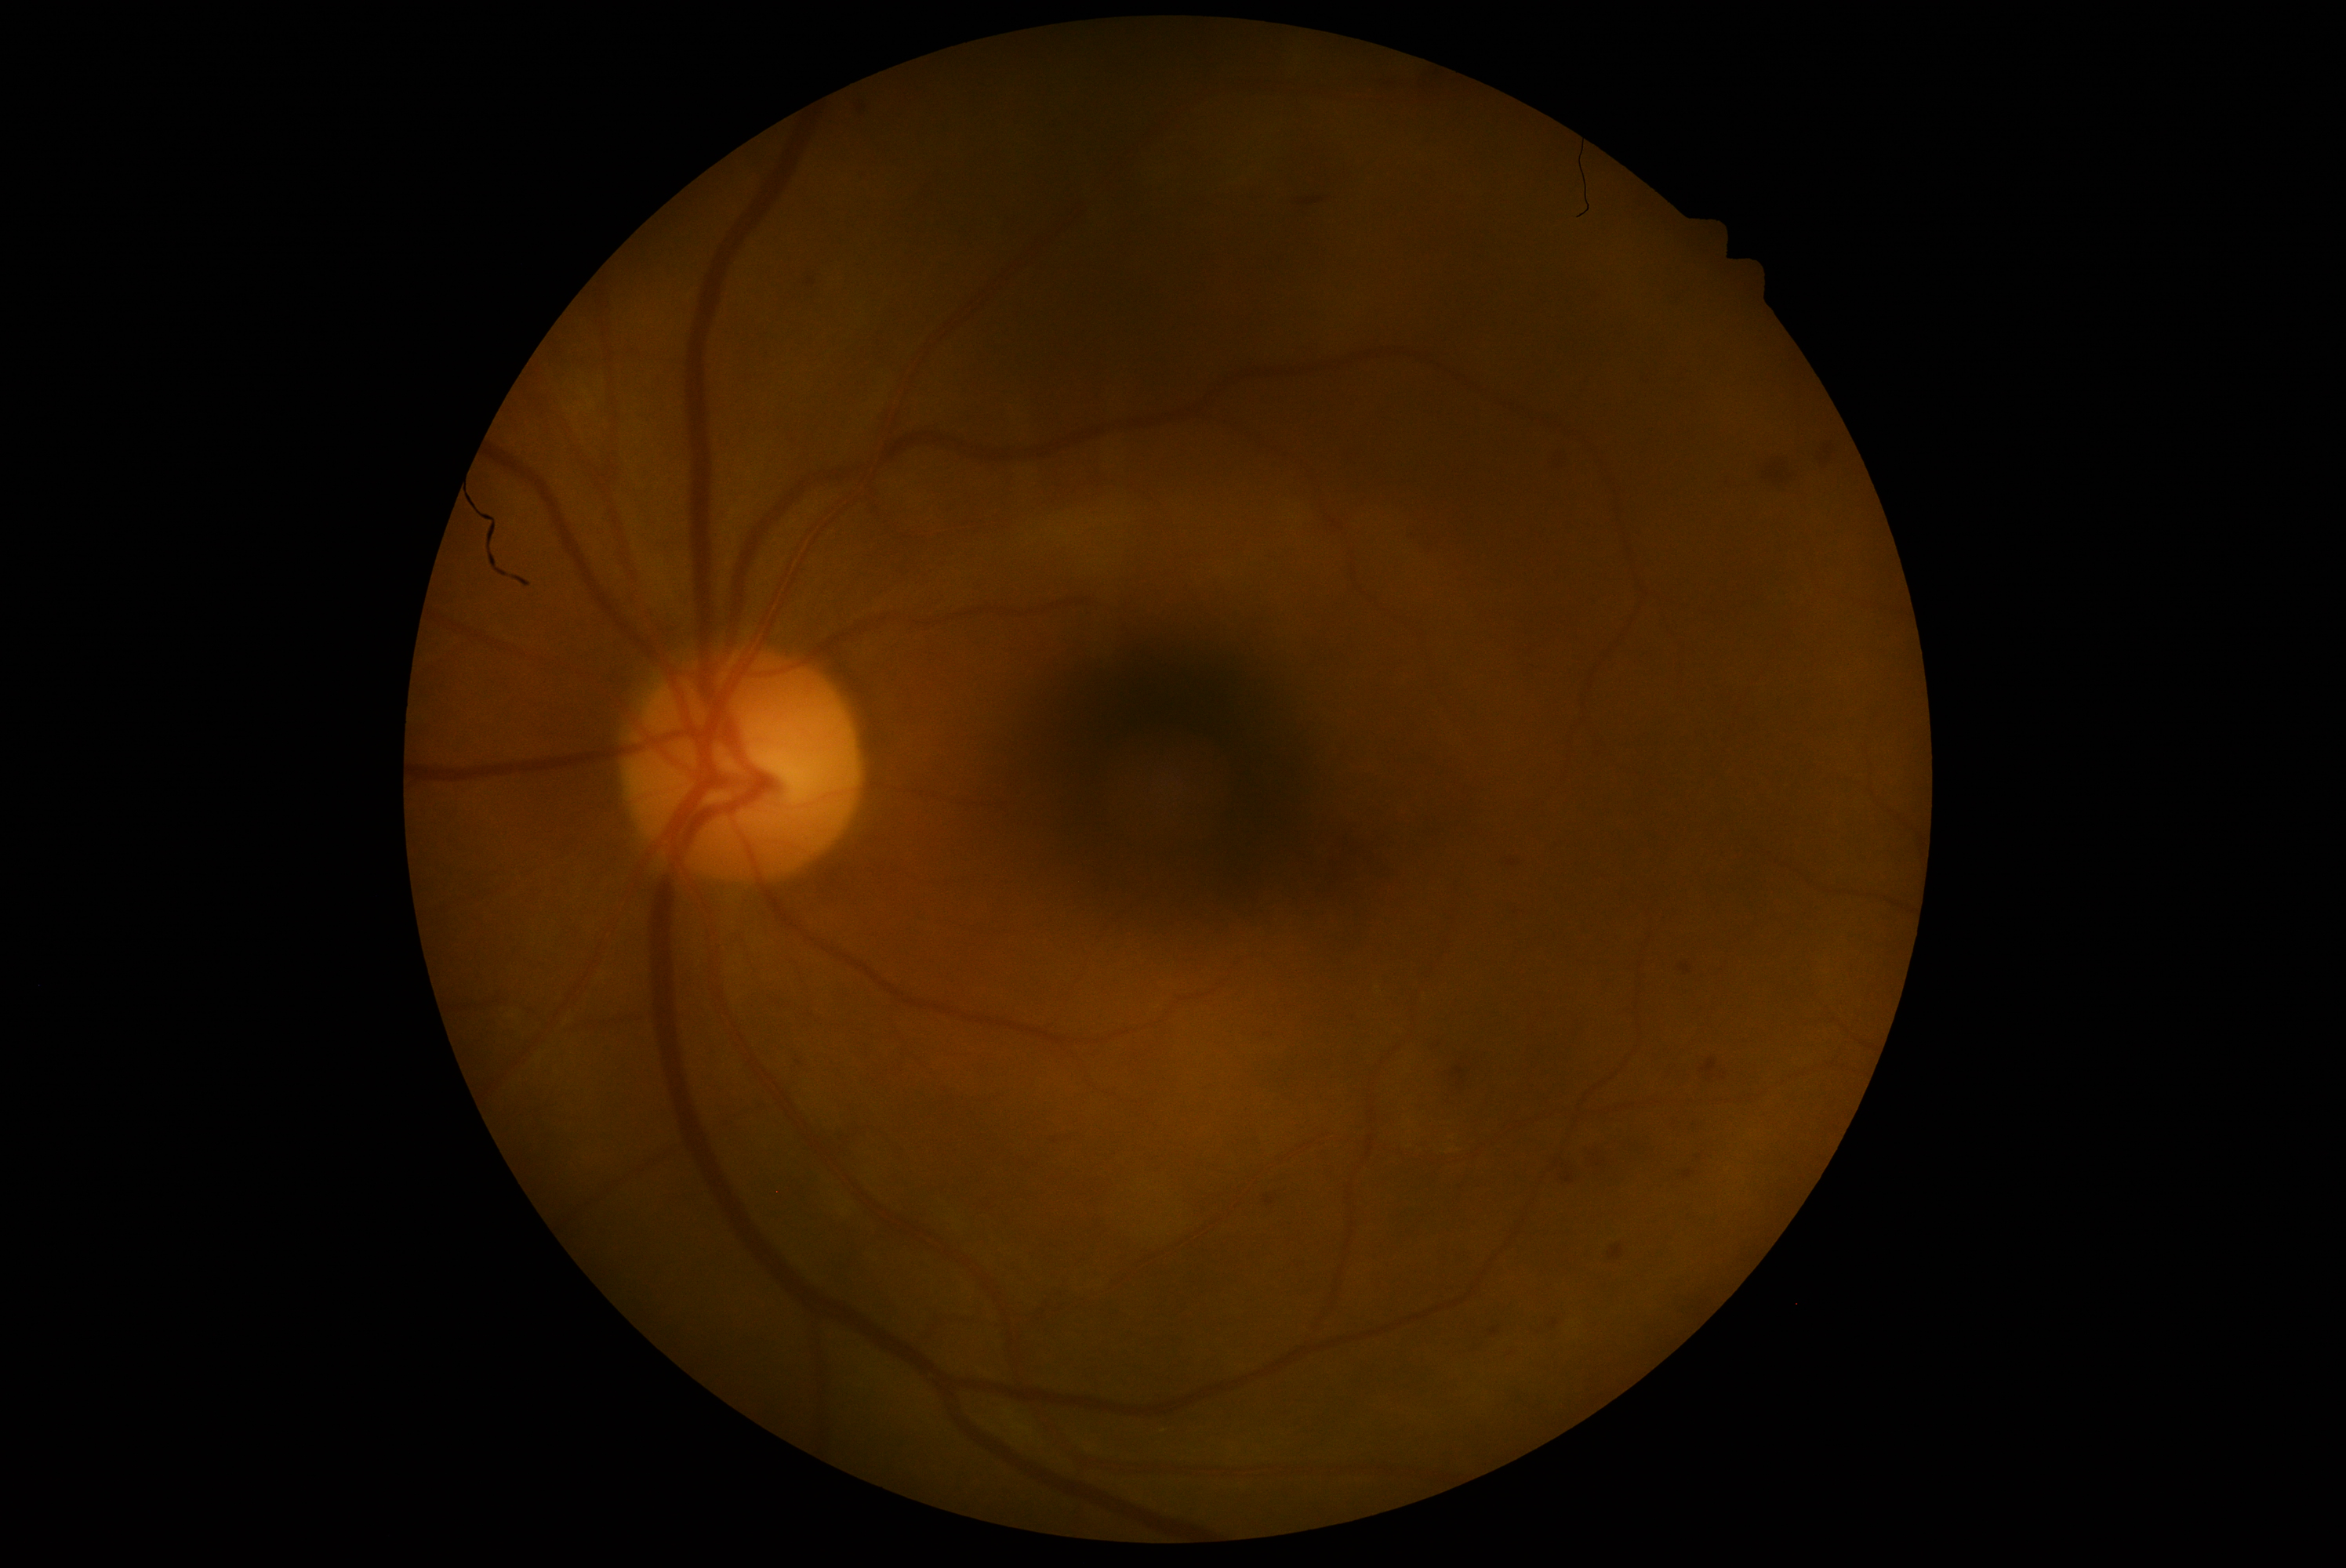

Diabetic retinopathy grade: 2 (moderate NPDR).